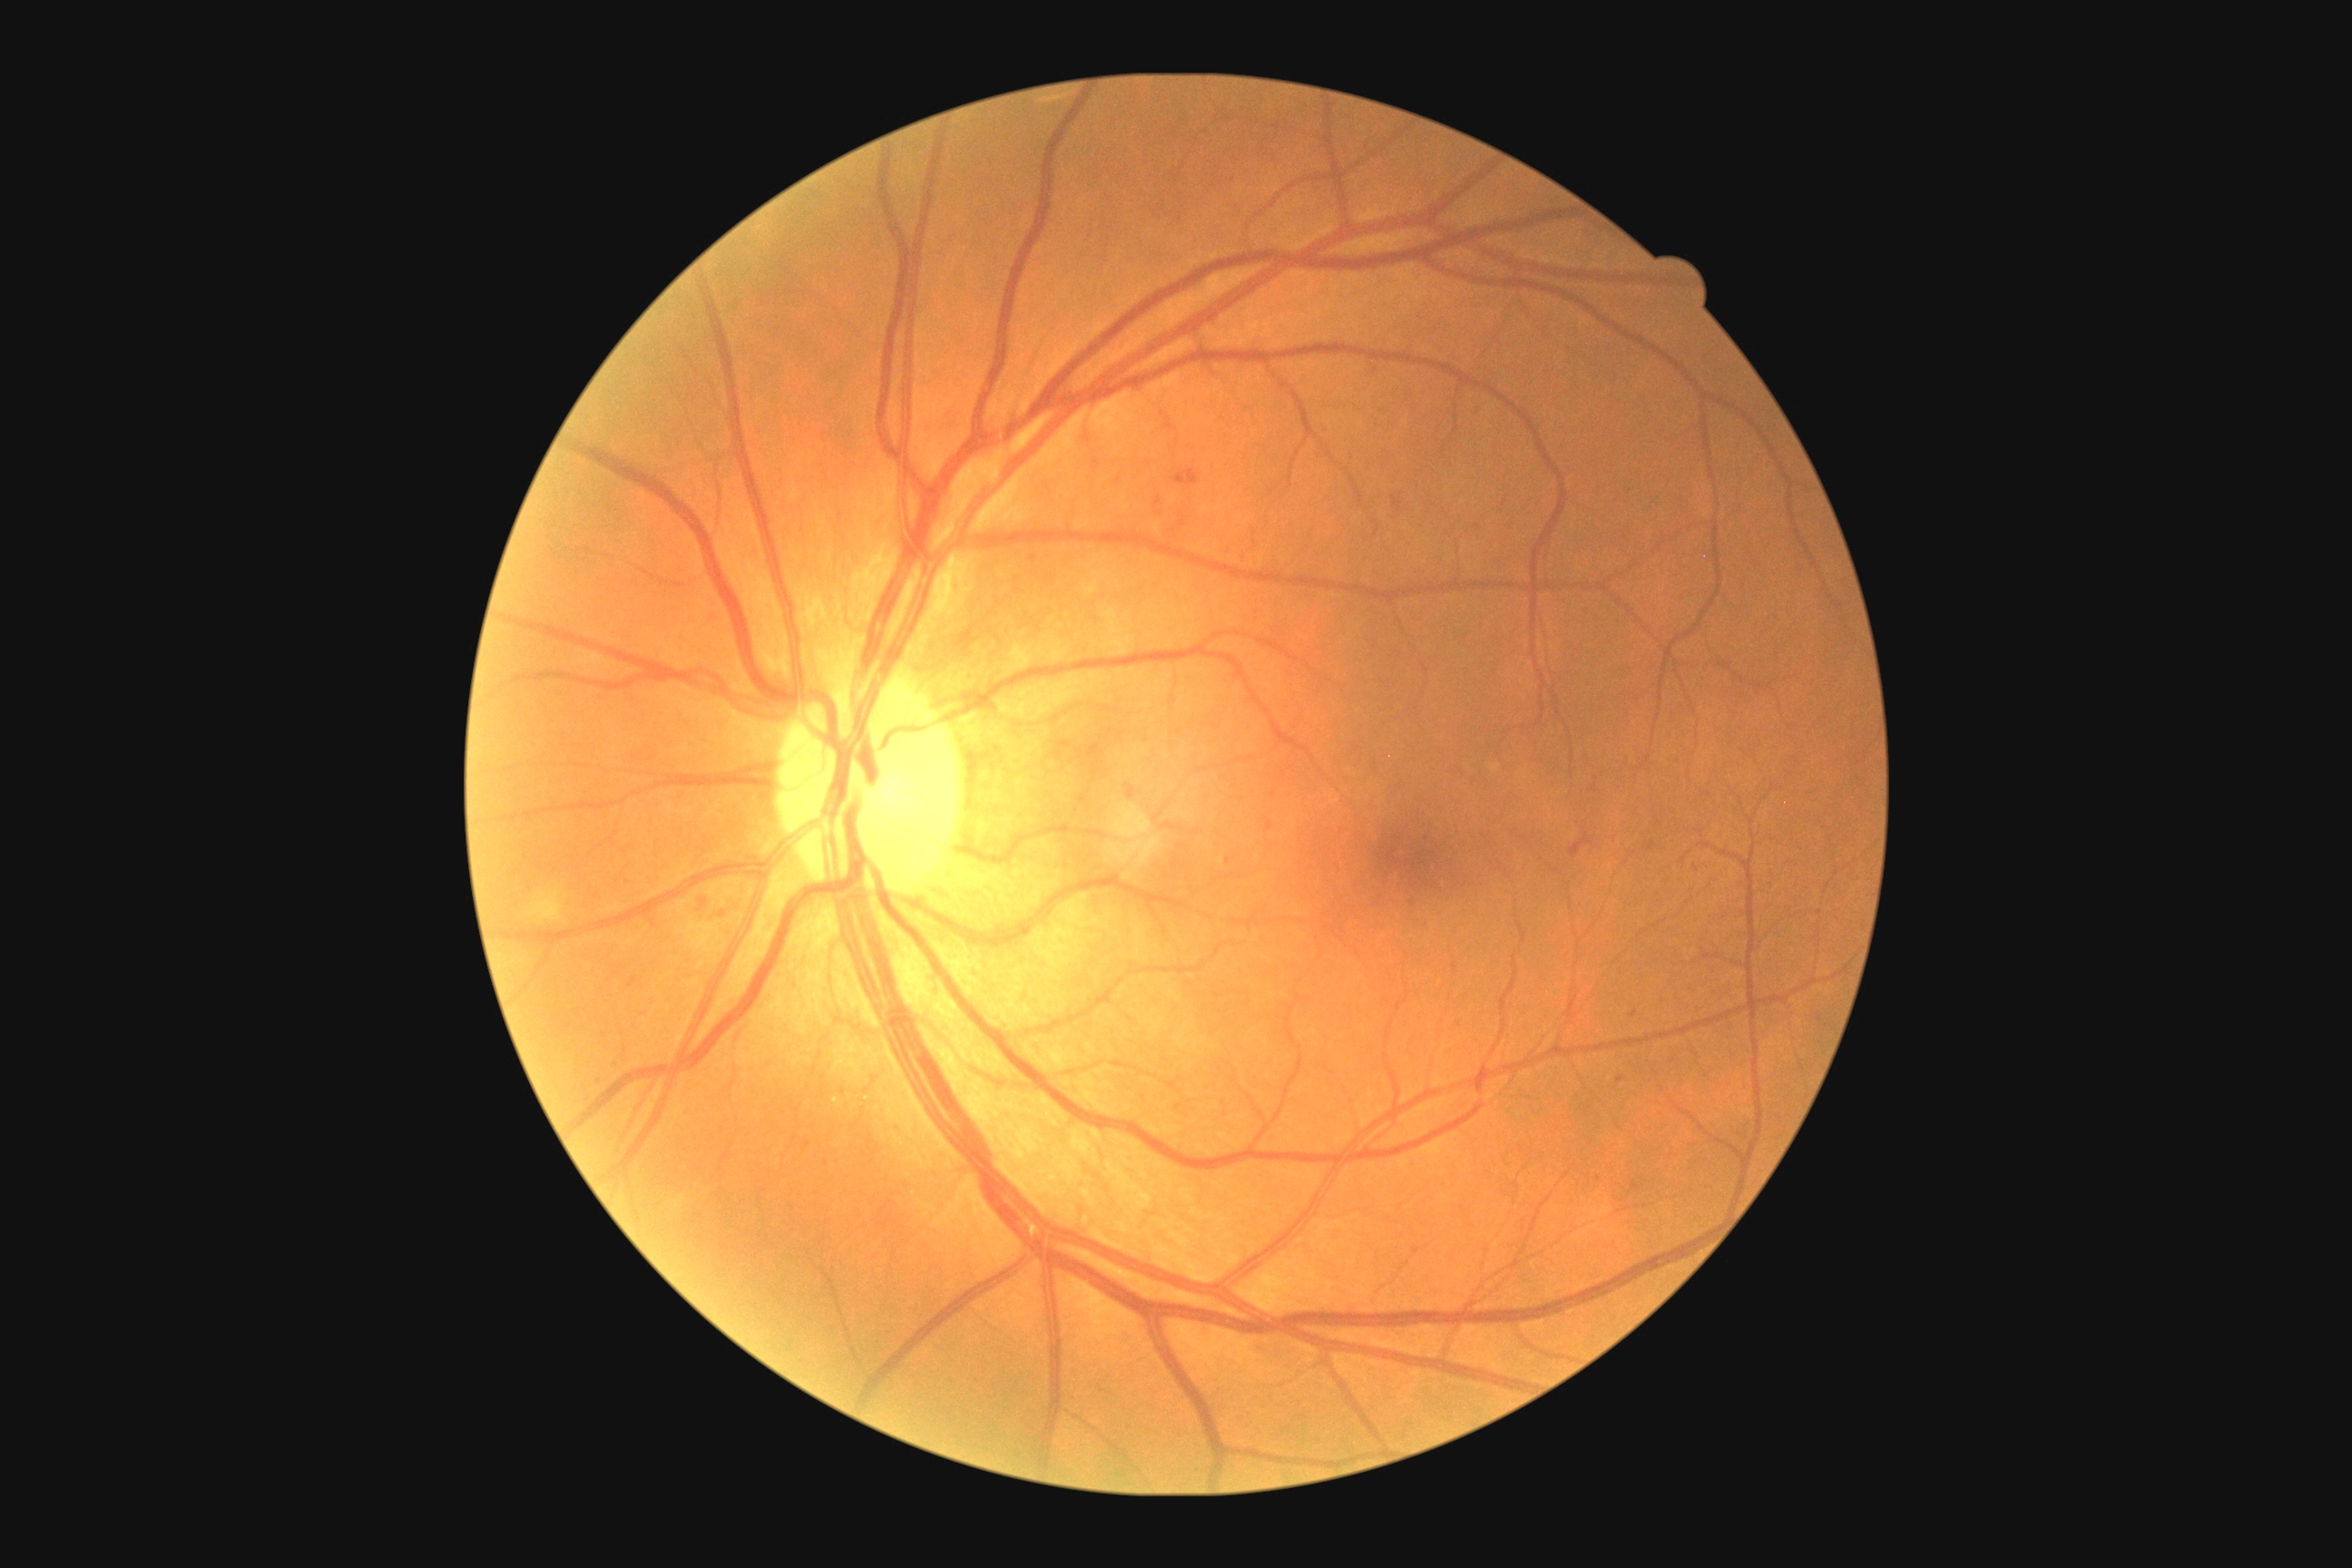 DR severity: grade 2 (moderate NPDR) — more than just microaneurysms but less than severe NPDR.